Retinal fundus photograph: 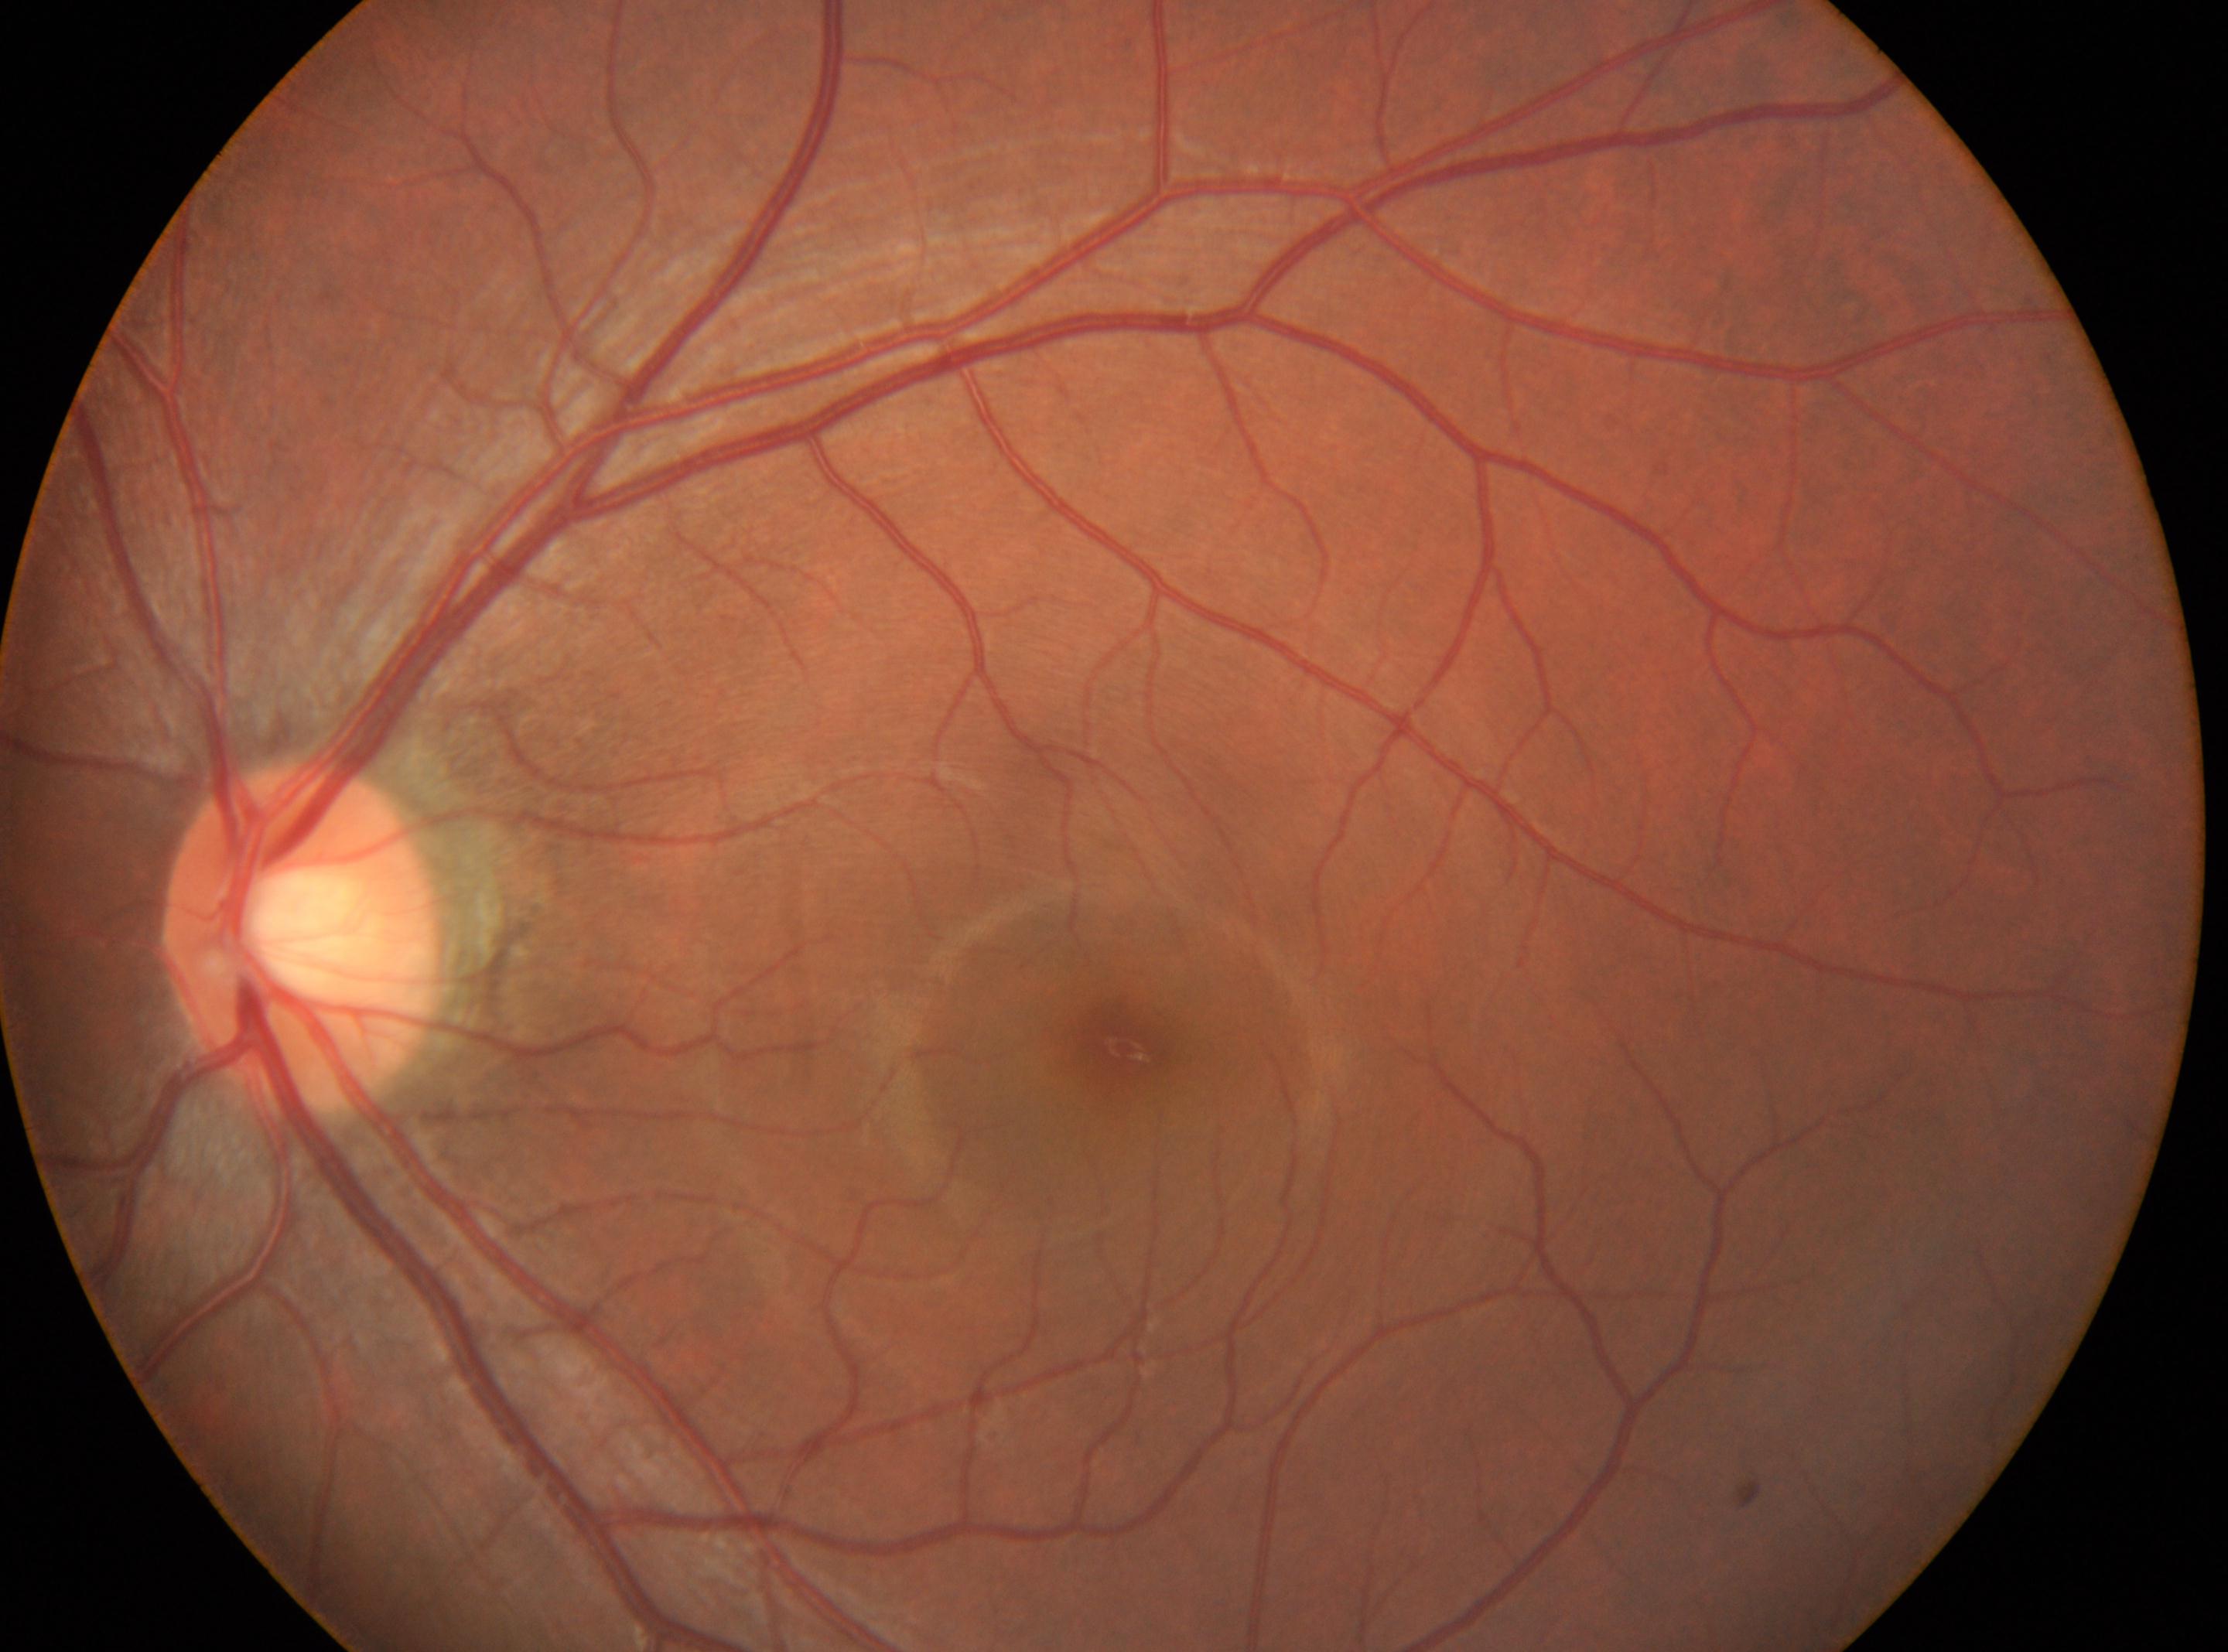 The disc center is at (306, 939). Diabetic retinopathy grade is no apparent retinopathy (0). The macula center is at (1122, 1047). Imaged eye: OS.